100° field of view (Phoenix ICON) · wide-field fundus photograph of an infant — 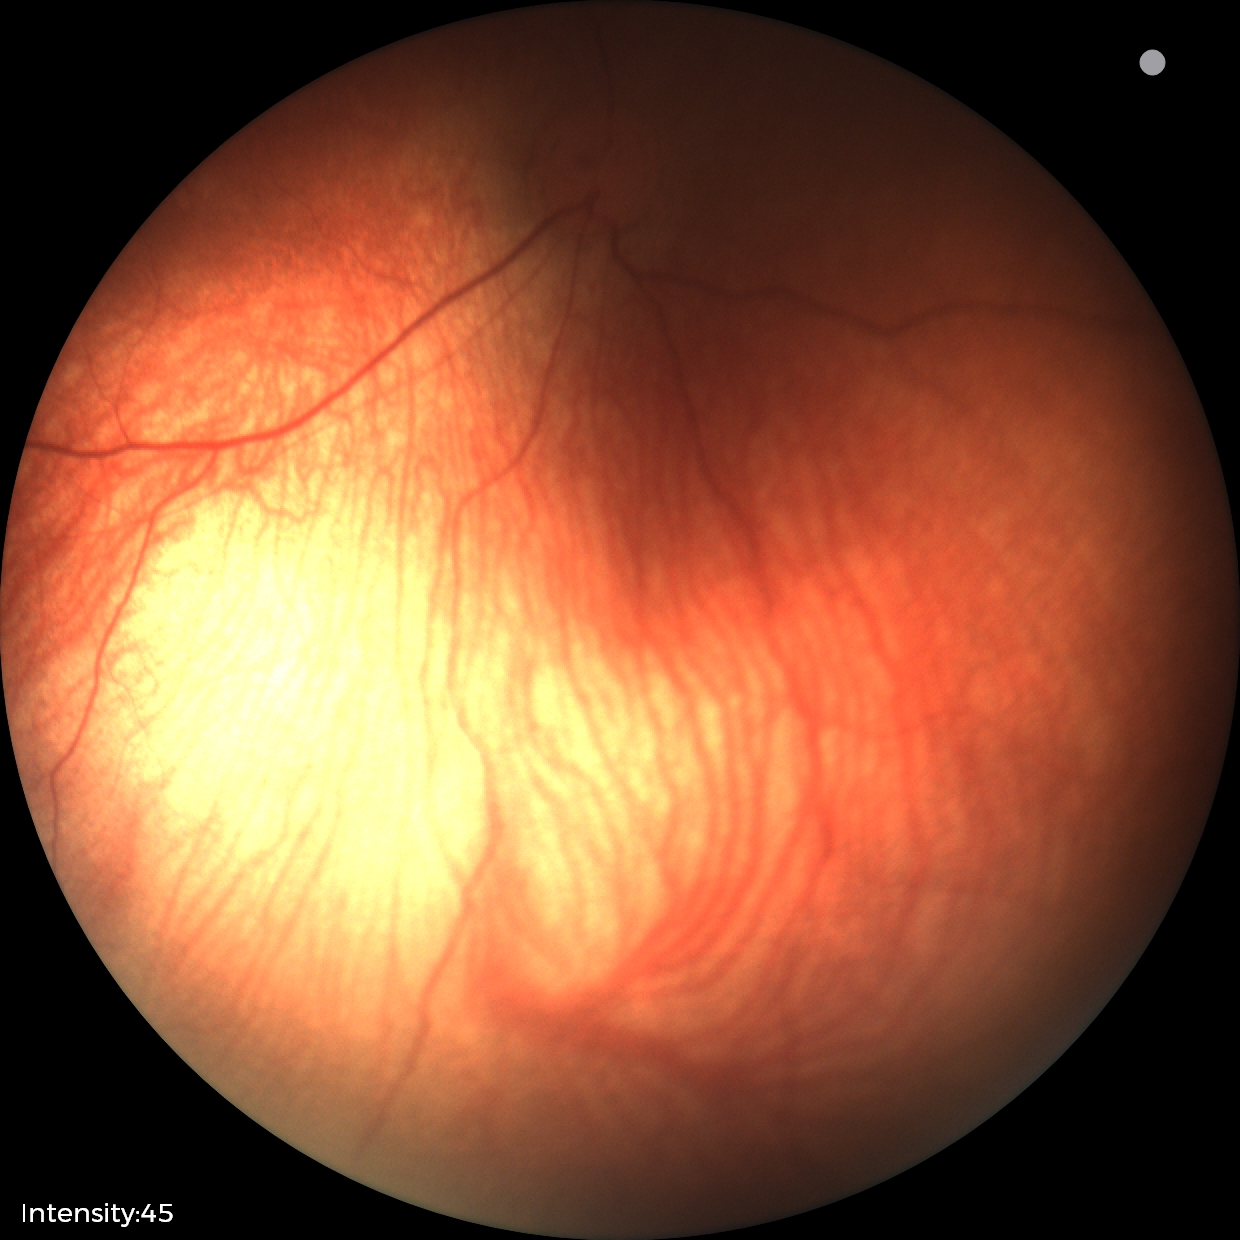 Examination with physiological retinal findings.